DR severity per modified Davis staging: 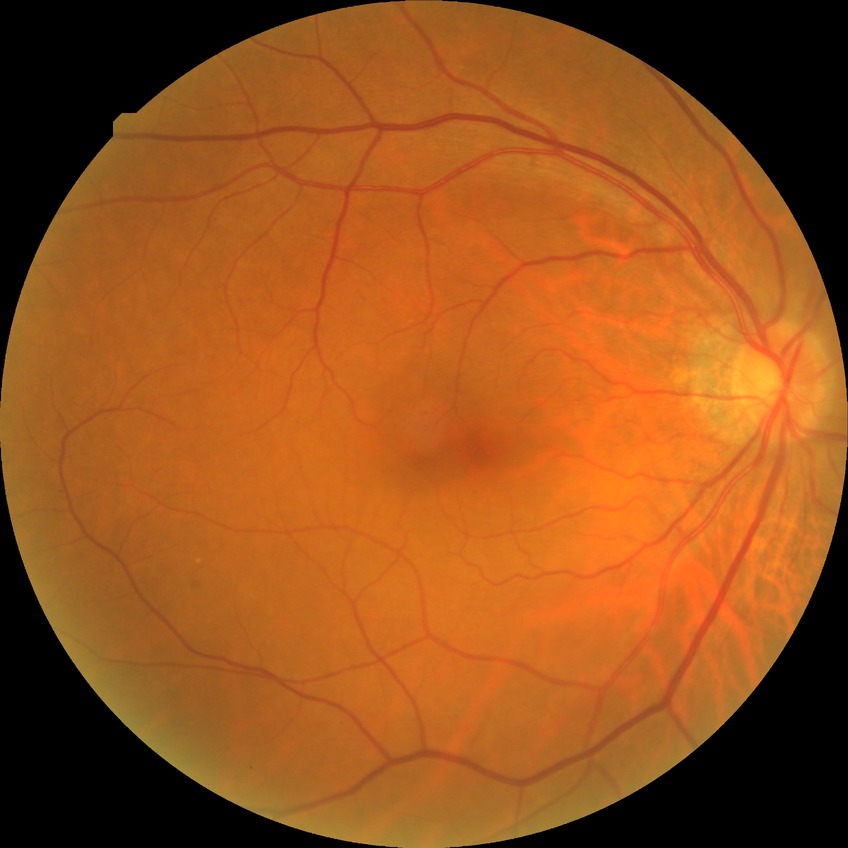 Retinopathy stage is no diabetic retinopathy.